RetCam wide-field infant fundus image — 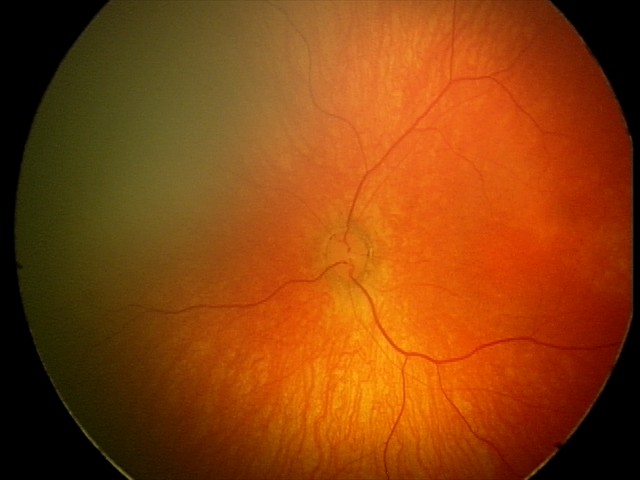

No retinal pathology identified on screening.